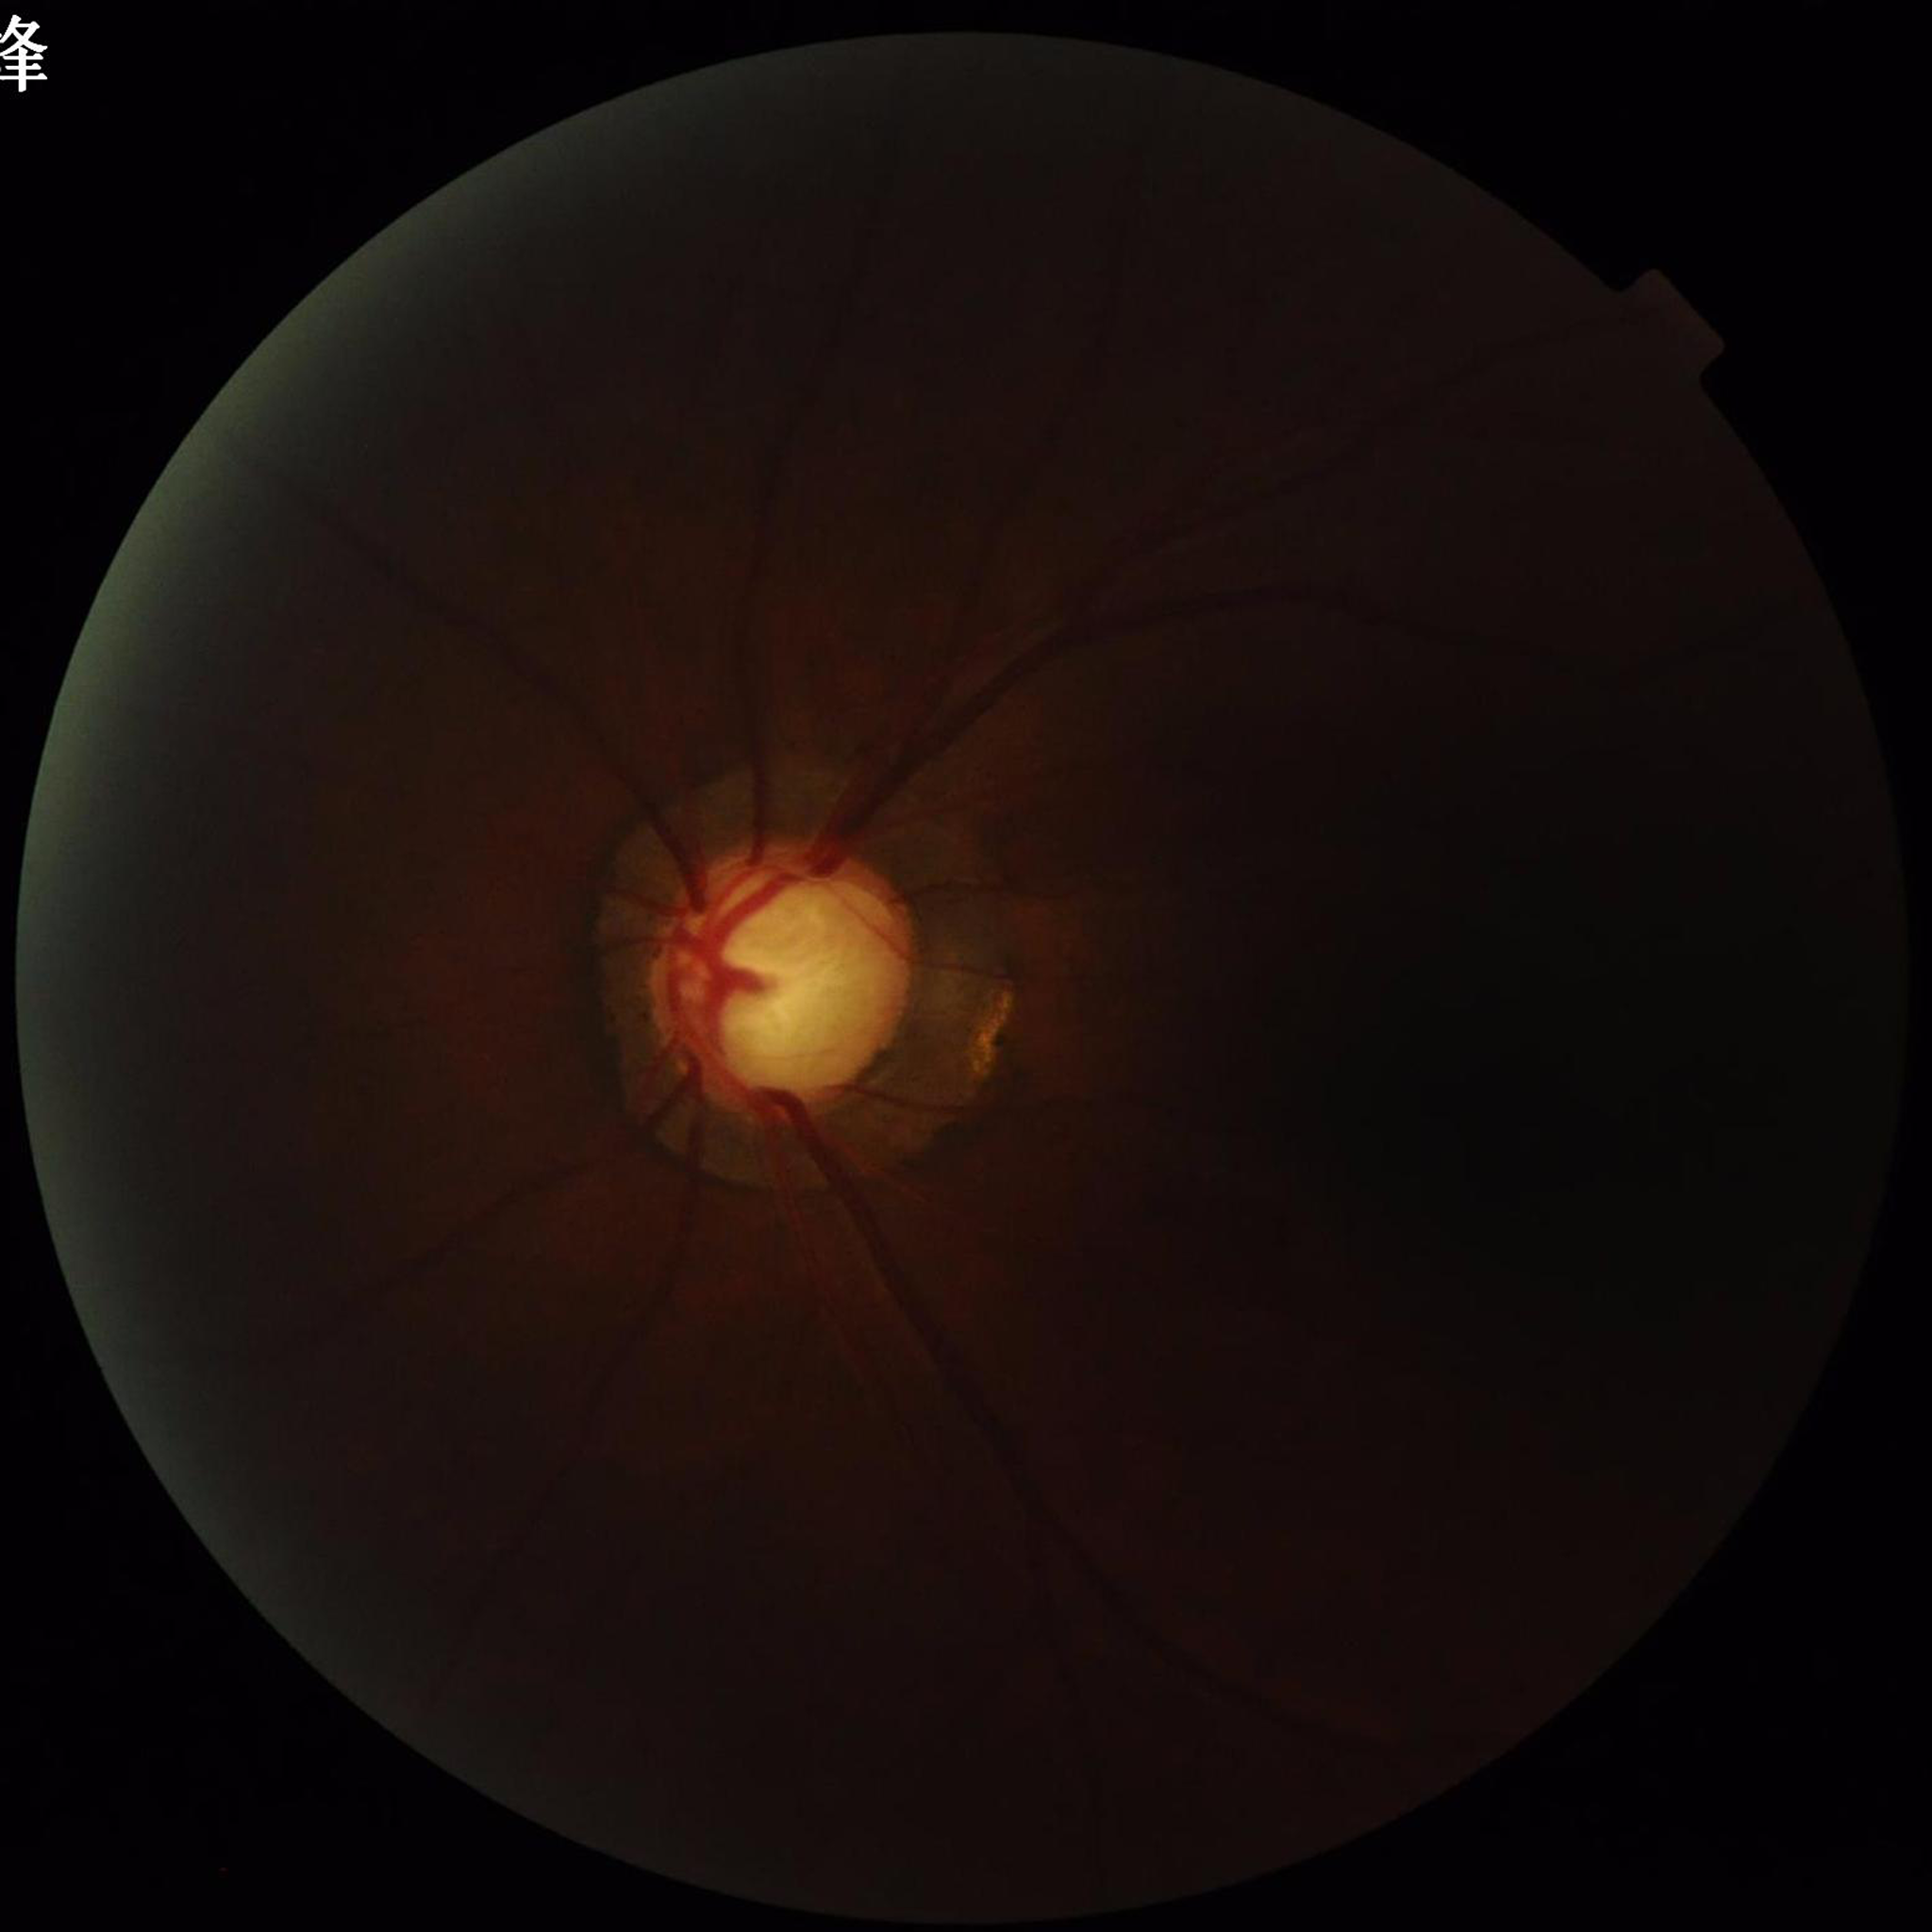
Quality assessment: poor — low contrast, blur, illumination/color distortion. Fundus image of an eye with glaucoma.